45° field of view.
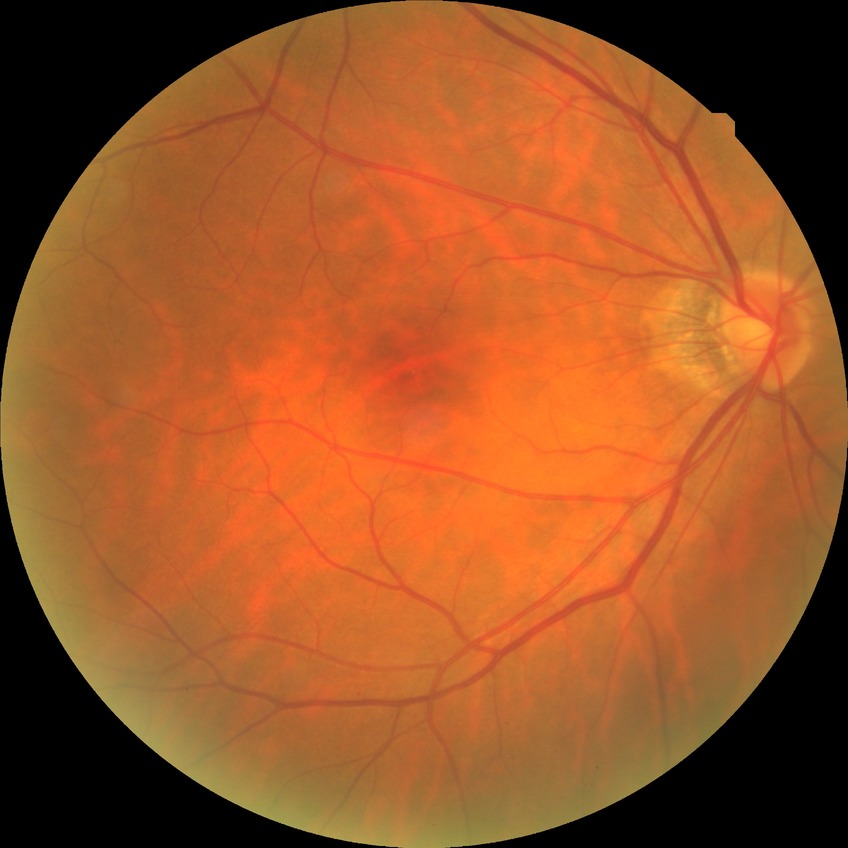
diabetic retinopathy (DR): simple diabetic retinopathy (SDR), DR class: non-proliferative diabetic retinopathy.